Wide-field fundus image from infant ROP screening: 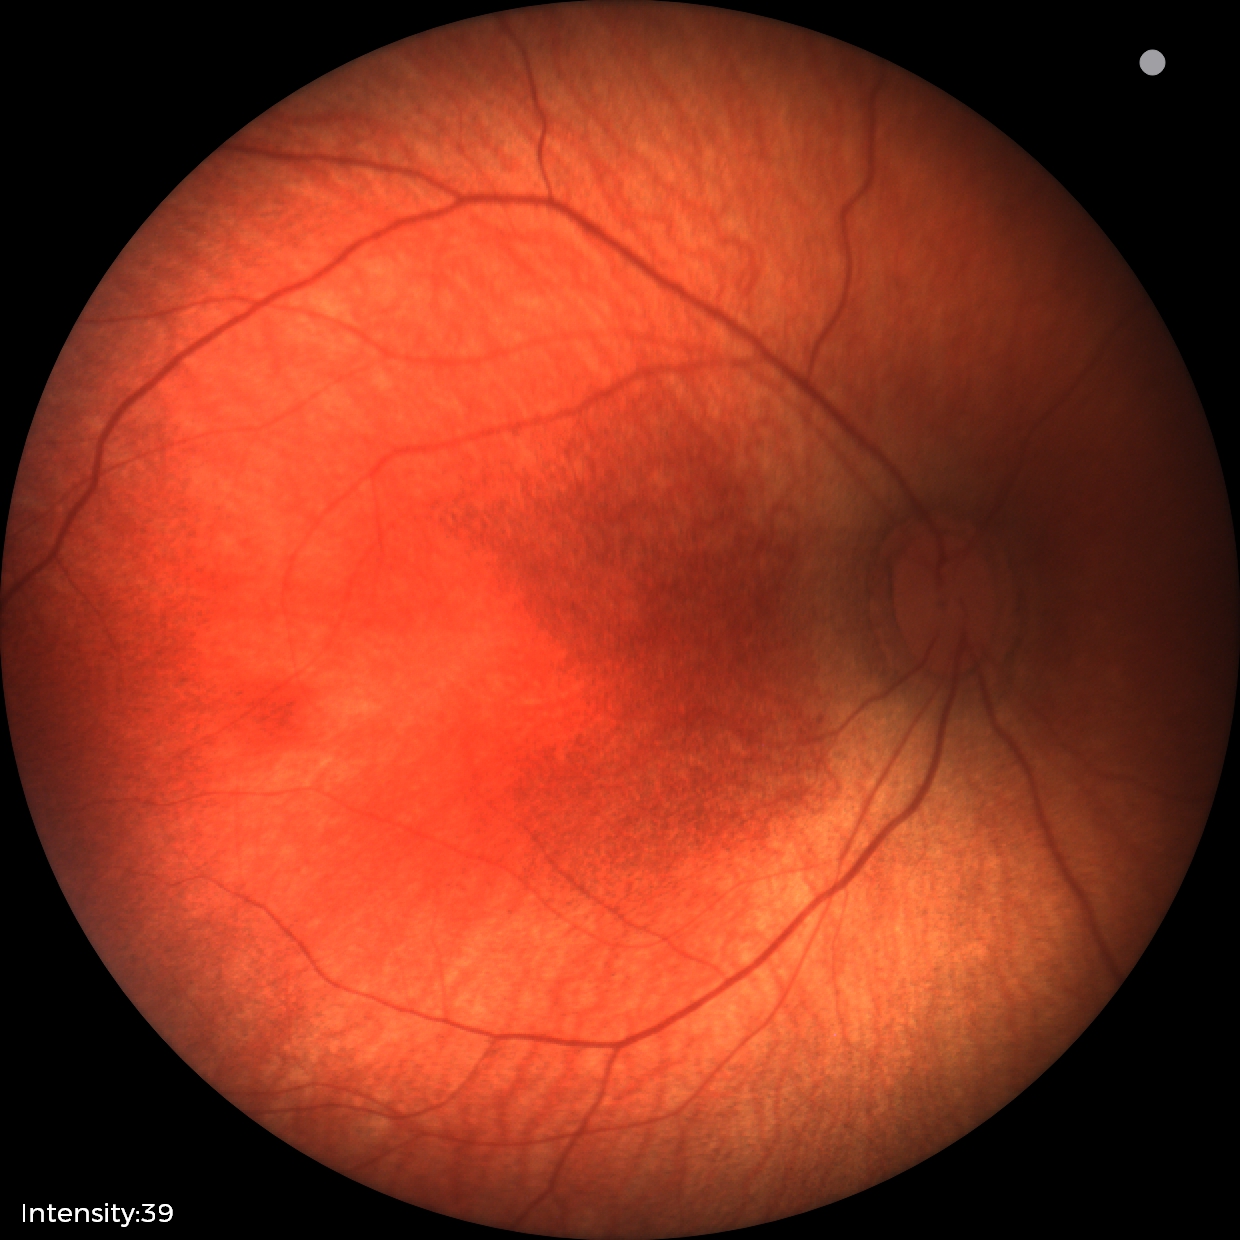

No retinal pathology identified on screening.